CFP; 2212 by 1672 pixels: 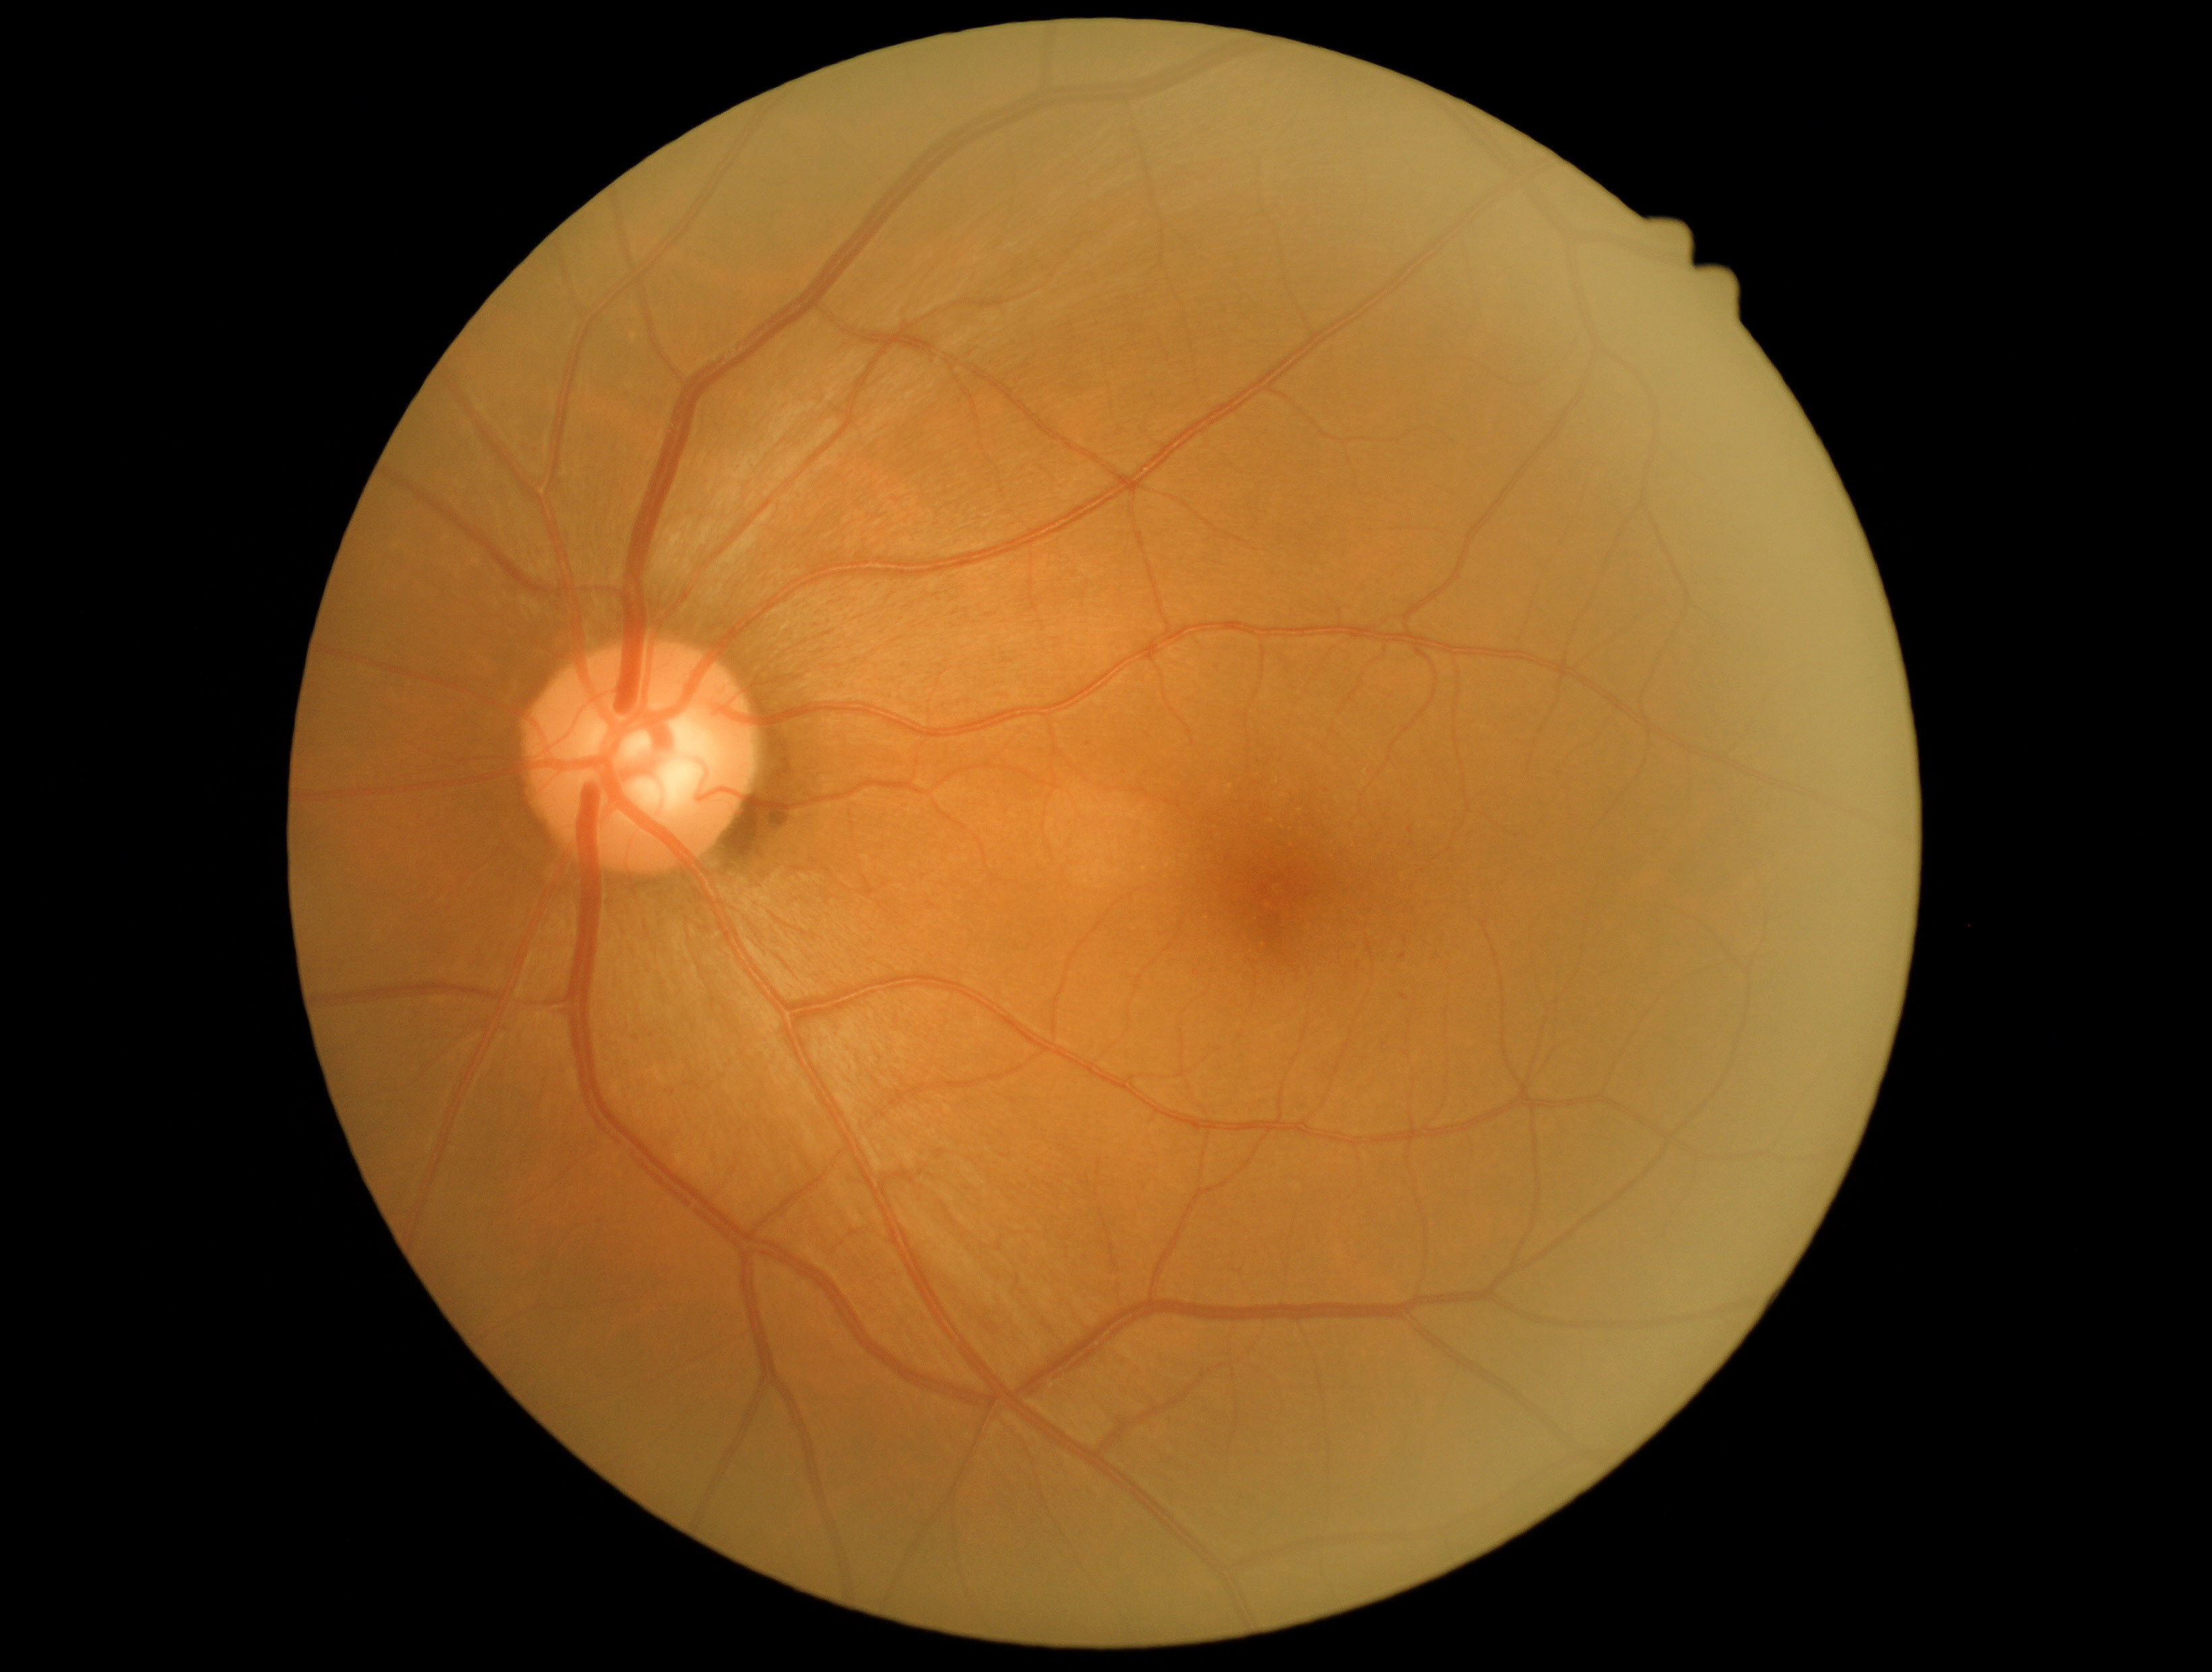 diabetic retinopathy severity: grade 1 (mild NPDR); DR class: non-proliferative diabetic retinopathy.